Davis DR grading
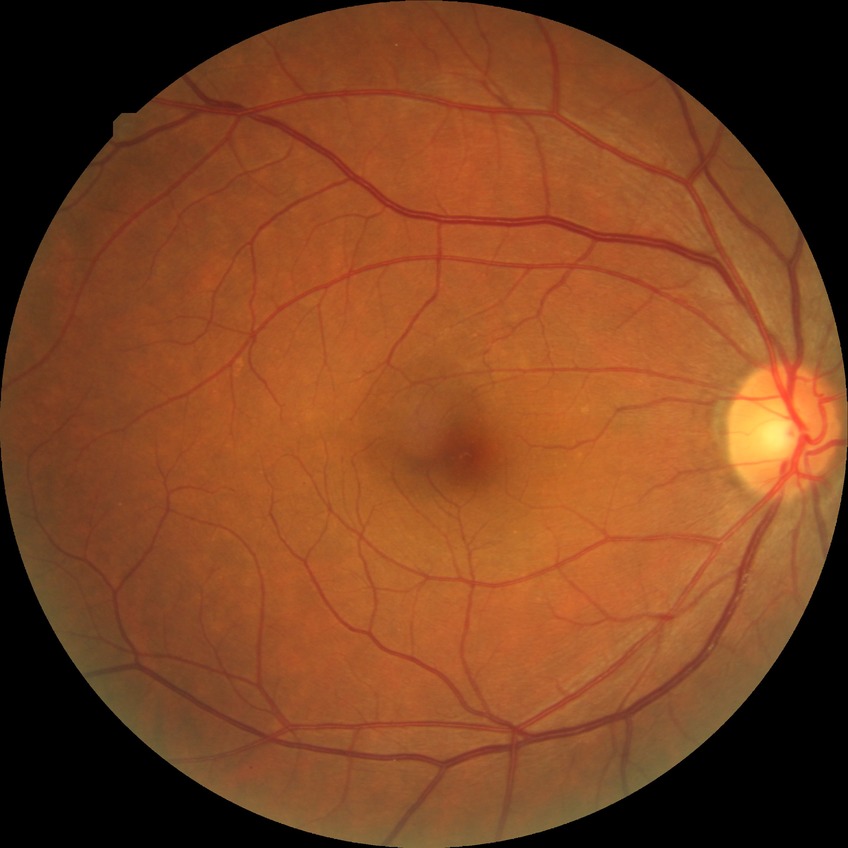
Diabetic retinopathy (DR): NDR (no diabetic retinopathy).